Camera: Phoenix ICON (100° FOV); infant wide-field retinal image.
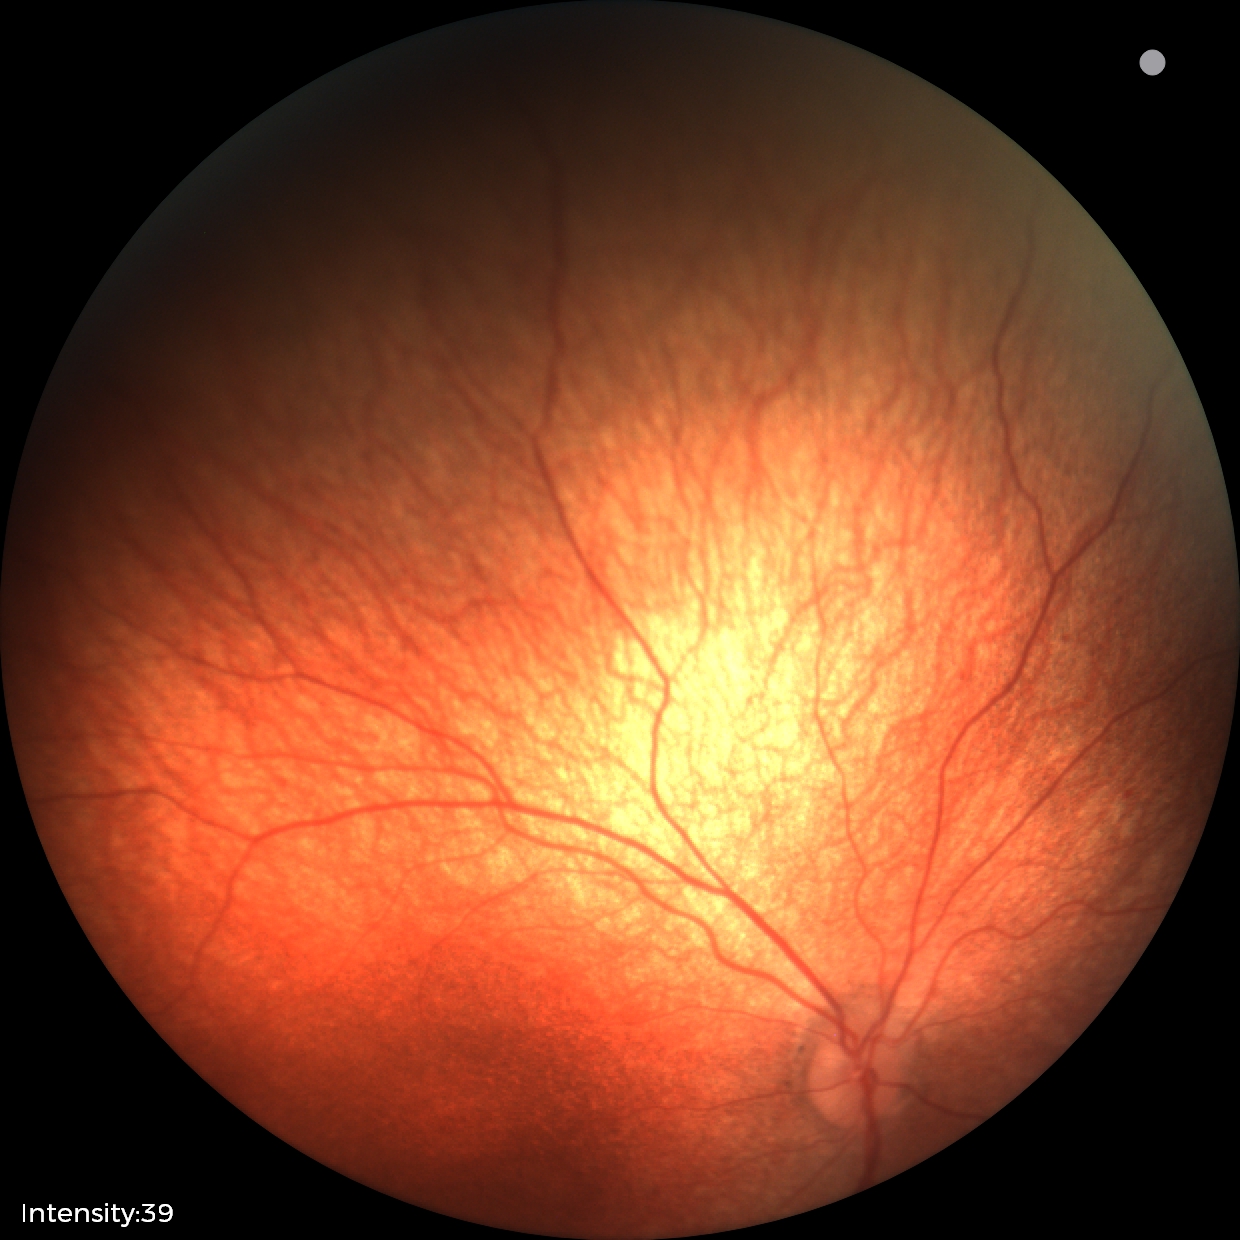

Physiological retinal appearance for postconceptual age.